2048x1536px — 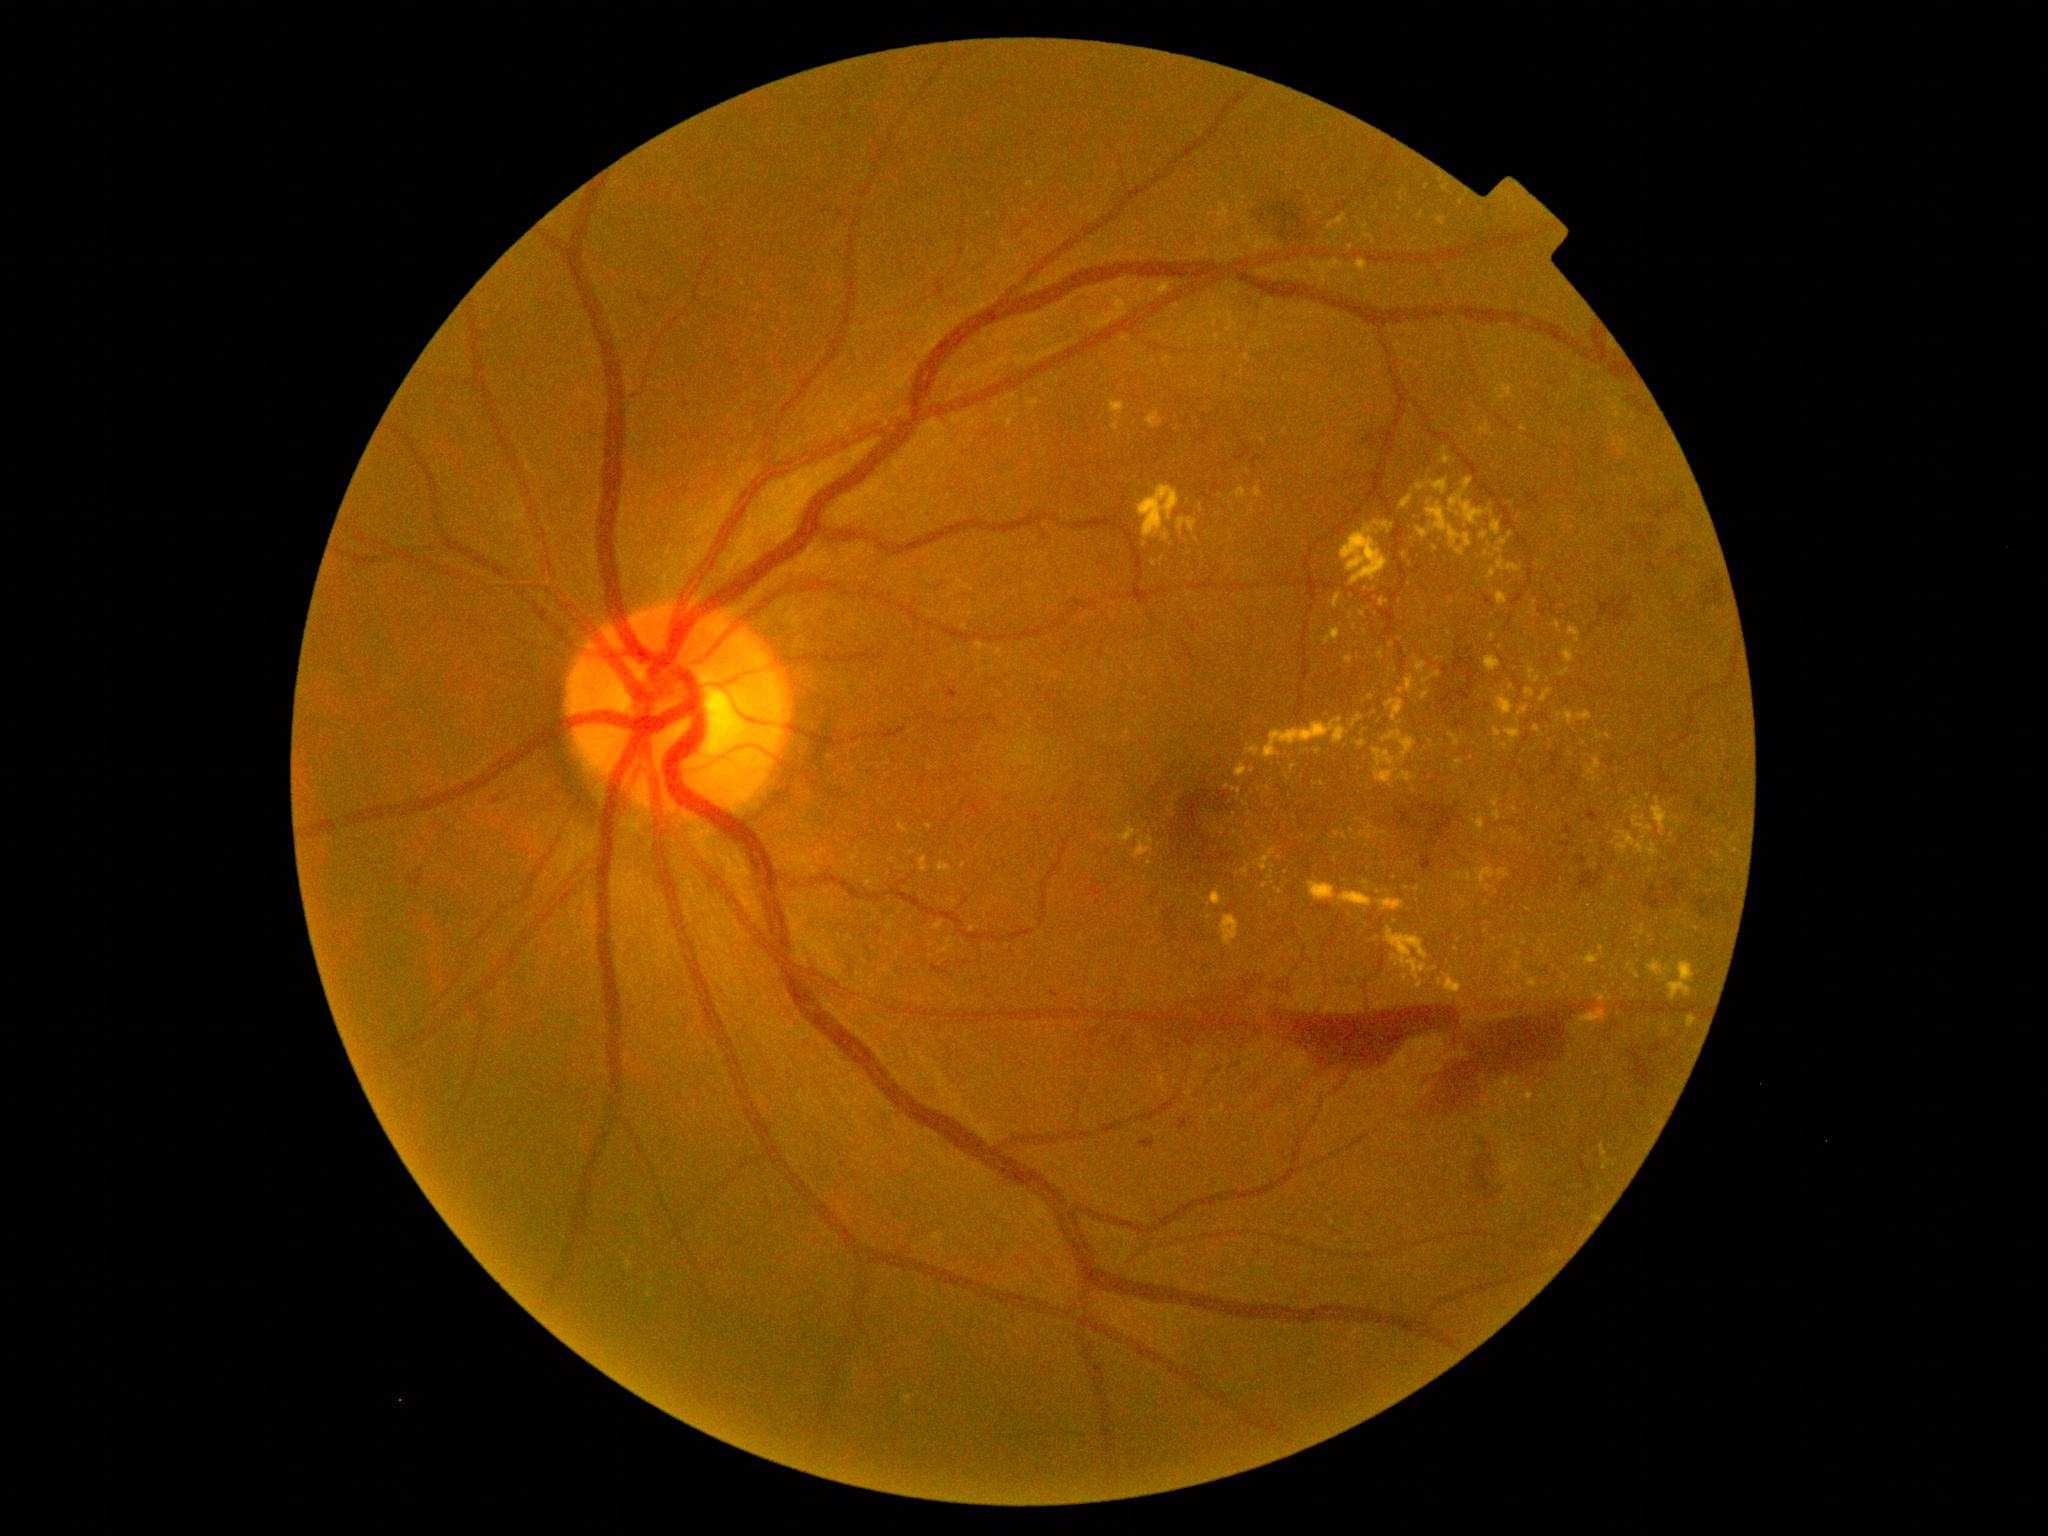
partial: true
dr_grade: 4
lesions:
  ex:
    - (left=1596, top=995, right=1606, bottom=1001)
    - (left=1327, top=215, right=1347, bottom=229)
    - (left=1427, top=503, right=1473, bottom=547)
    - (left=1260, top=849, right=1277, bottom=872)
    - (left=1212, top=892, right=1222, bottom=906)
    - (left=1529, top=979, right=1537, bottom=988)
    - (left=1569, top=629, right=1582, bottom=643)
    - (left=1507, top=564, right=1520, bottom=573)
    - (left=934, top=922, right=944, bottom=931)
  ex_small_centers:
    - x=1643, y=926
    - x=1458, y=515
    - x=1318, y=752
    - x=1422, y=215
    - x=1644, y=818
    - x=1499, y=551
    - x=1399, y=210
    - x=964, y=866
    - x=1658, y=800
    - x=1218, y=338